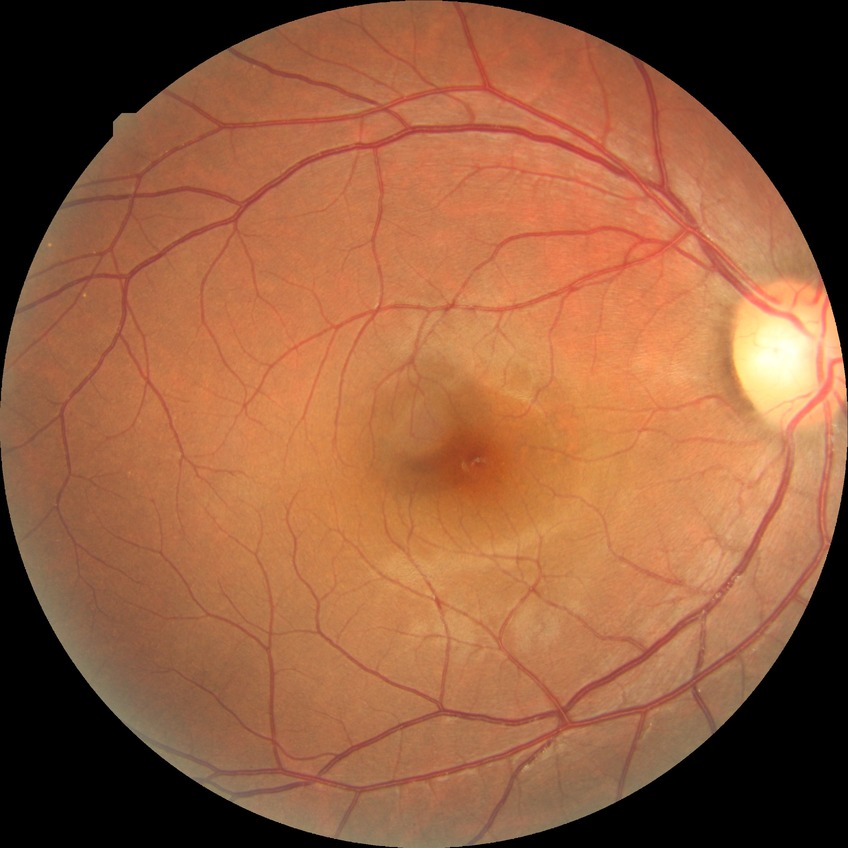 diabetic retinopathy (DR)=NDR (no diabetic retinopathy).